Infant wide-field retinal image.
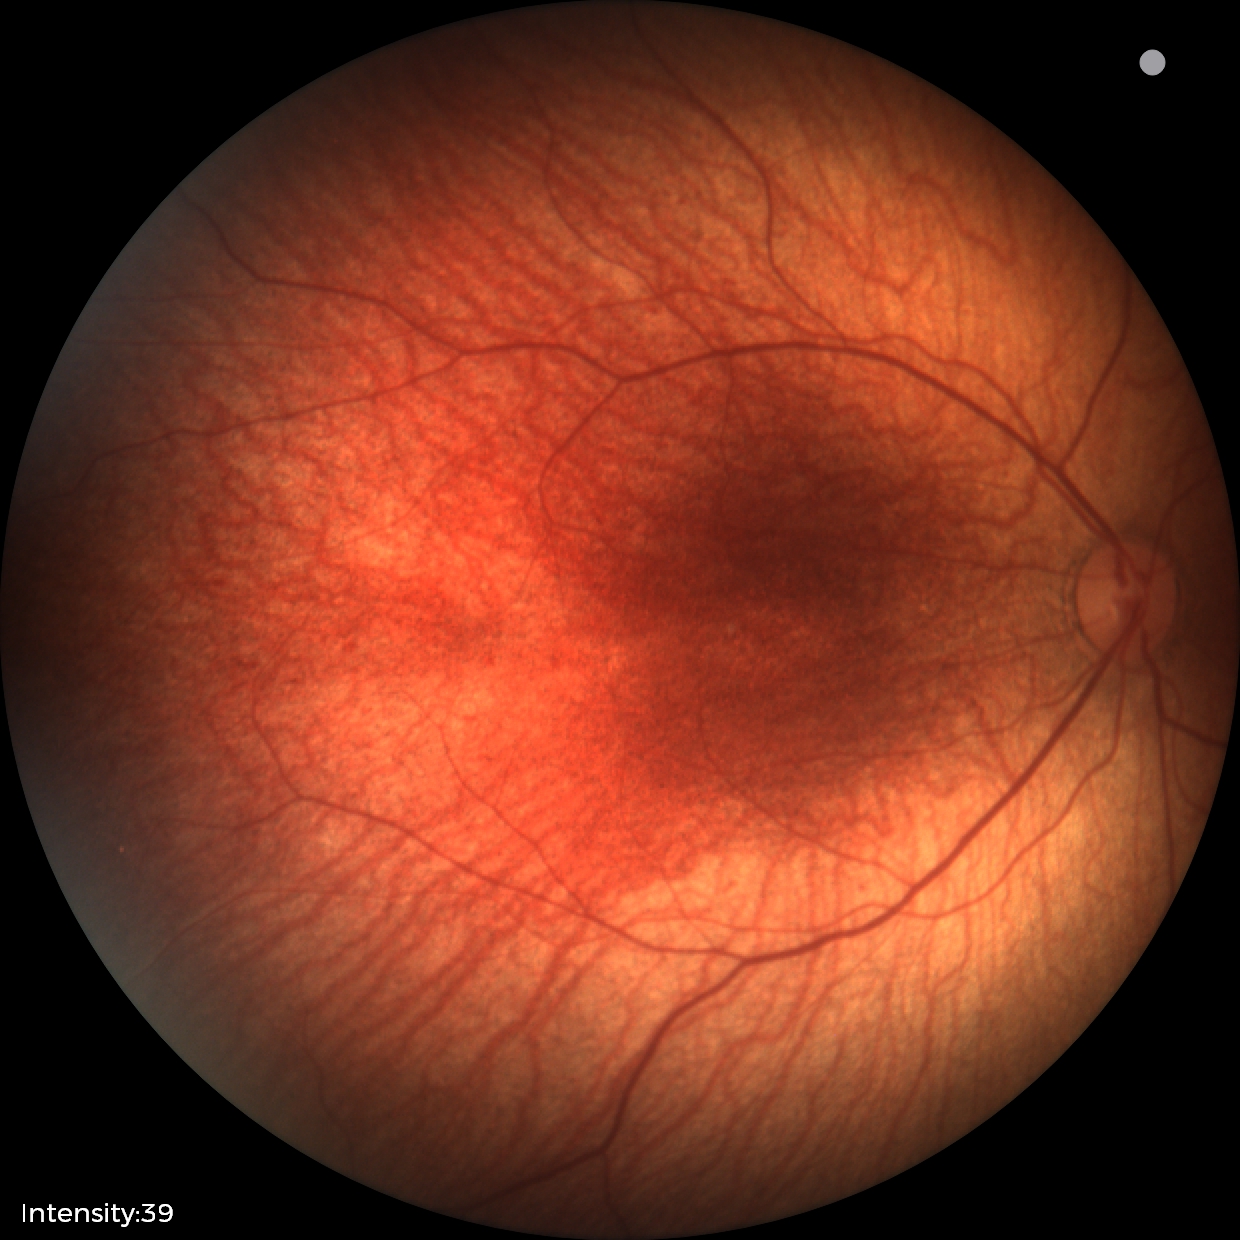 Screening examination with no abnormal retinal findings.